Image size 1380x1382: 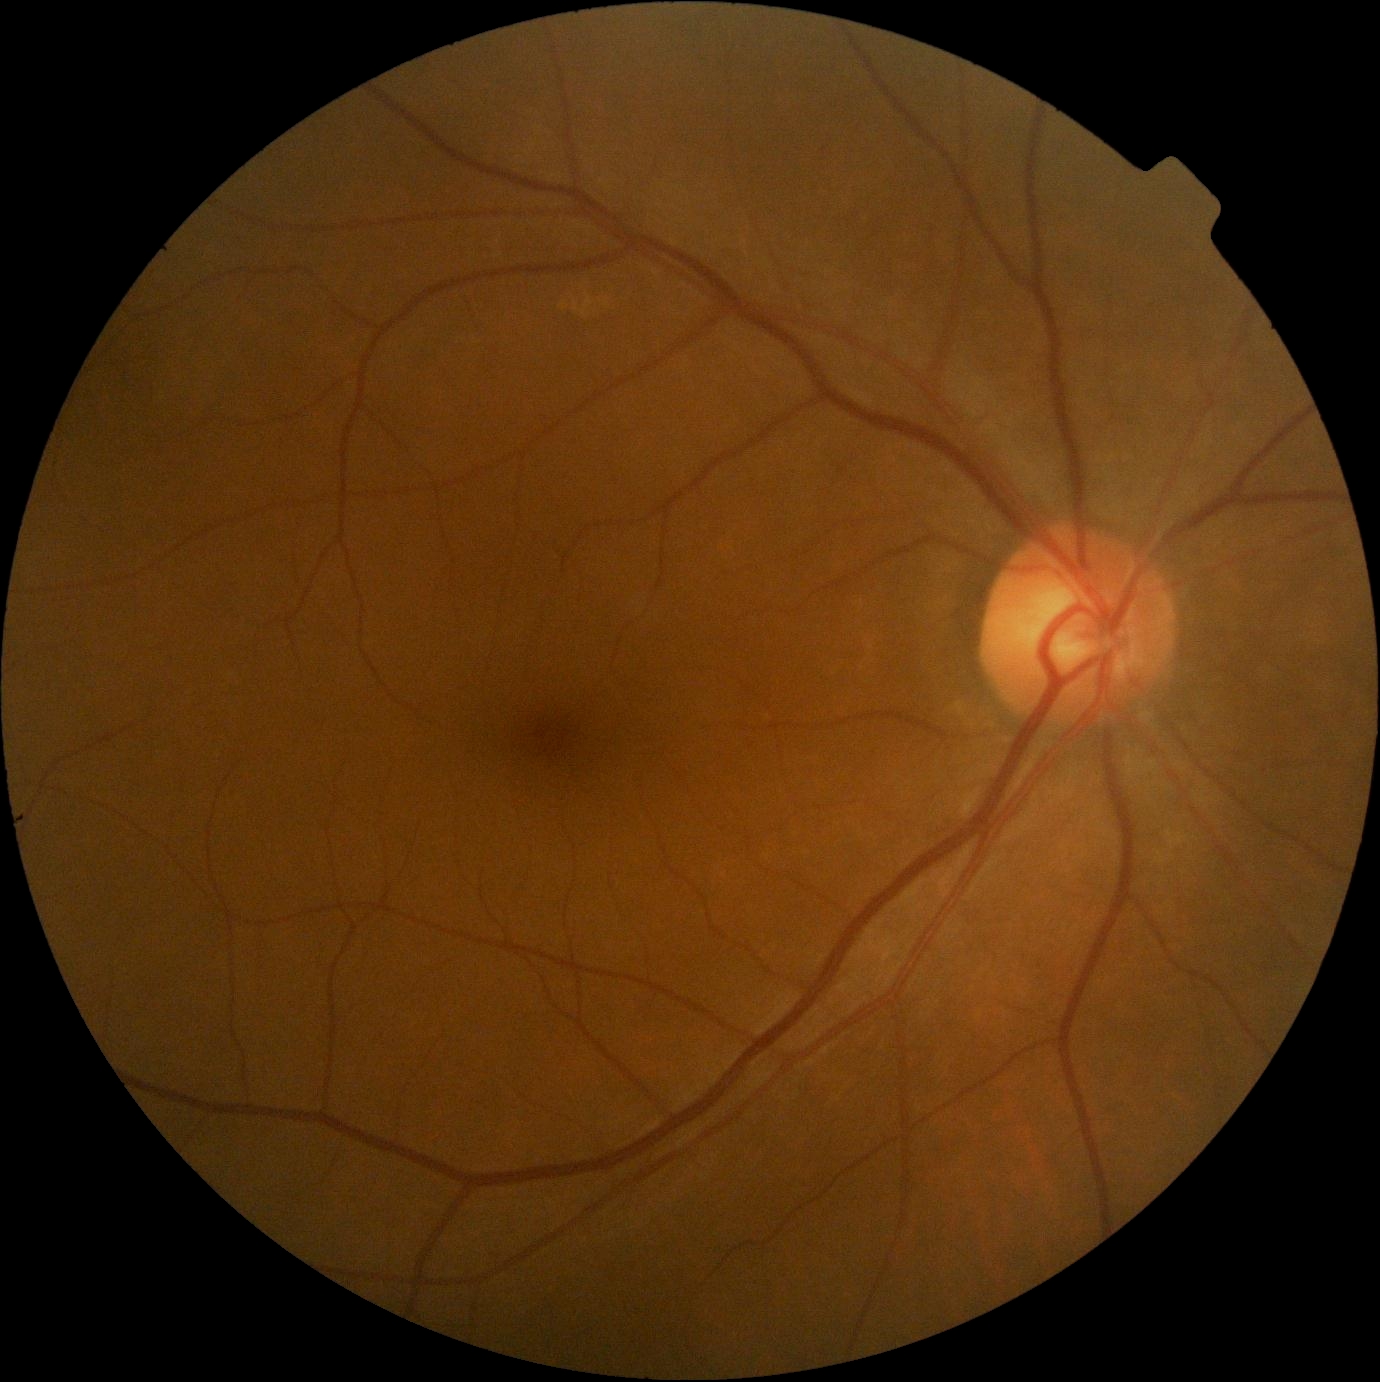

Diabetic retinopathy severity: grade 0 (no apparent retinopathy).